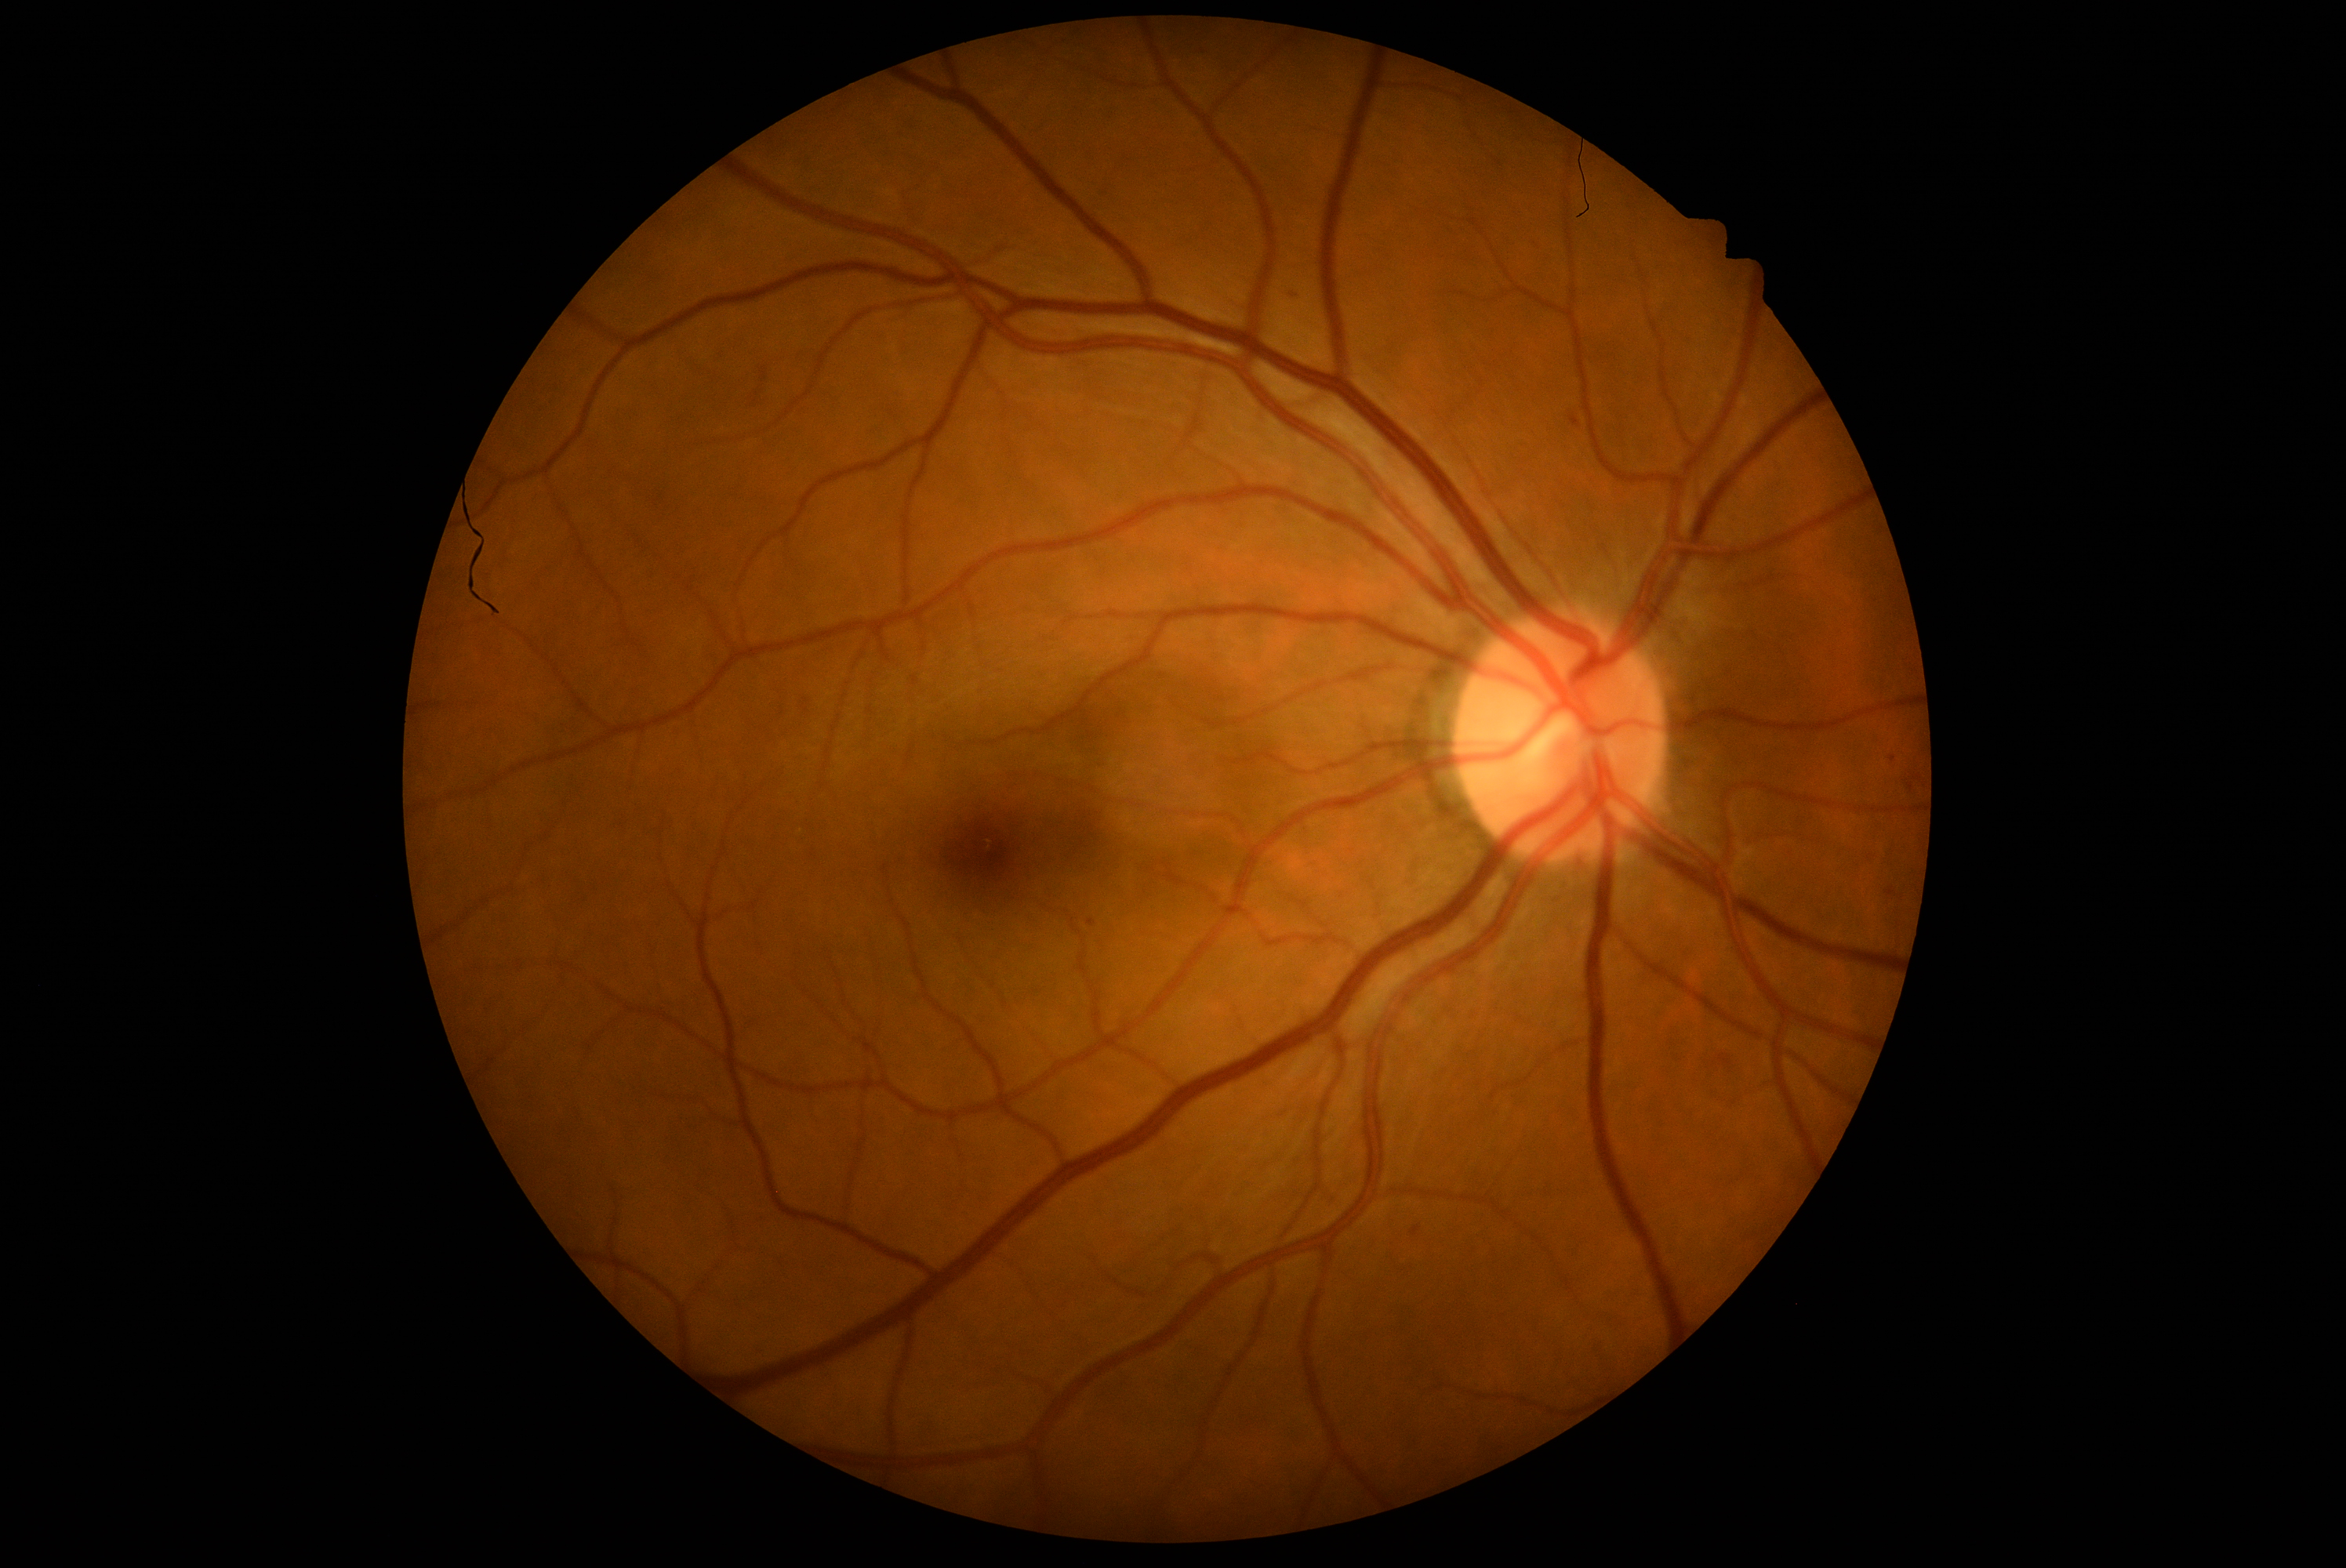 DR severity: 1 — presence of microaneurysms only.